Graded on the modified Davis scale — 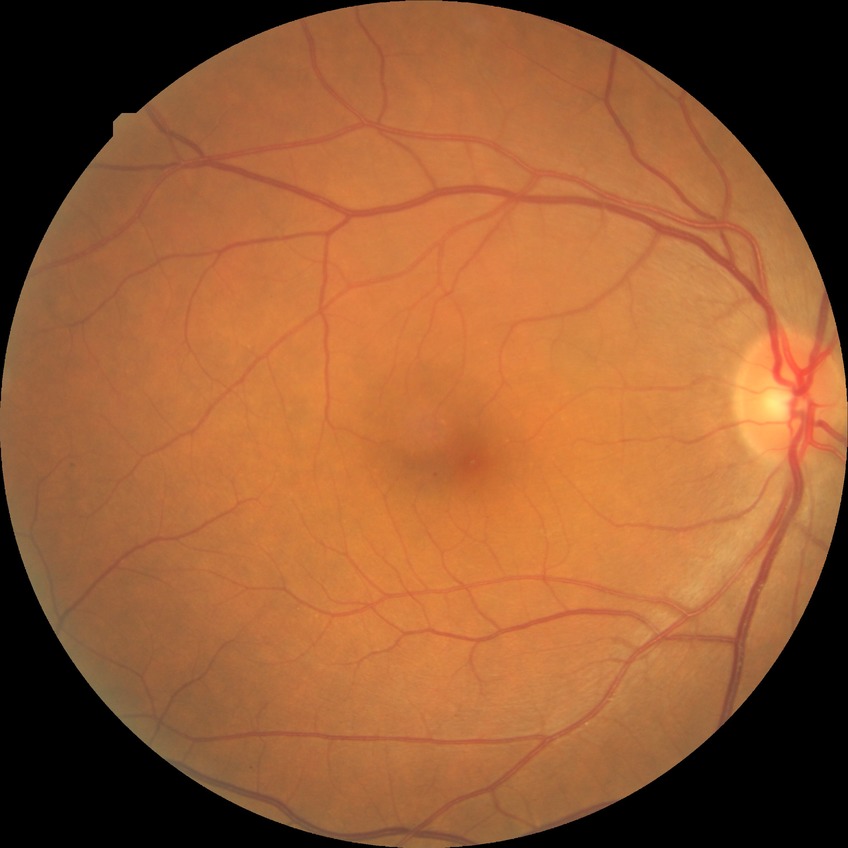 Diabetic retinopathy (DR): NDR (no diabetic retinopathy).